Fundus photo, 45° FOV, 2352 by 1568 pixels — 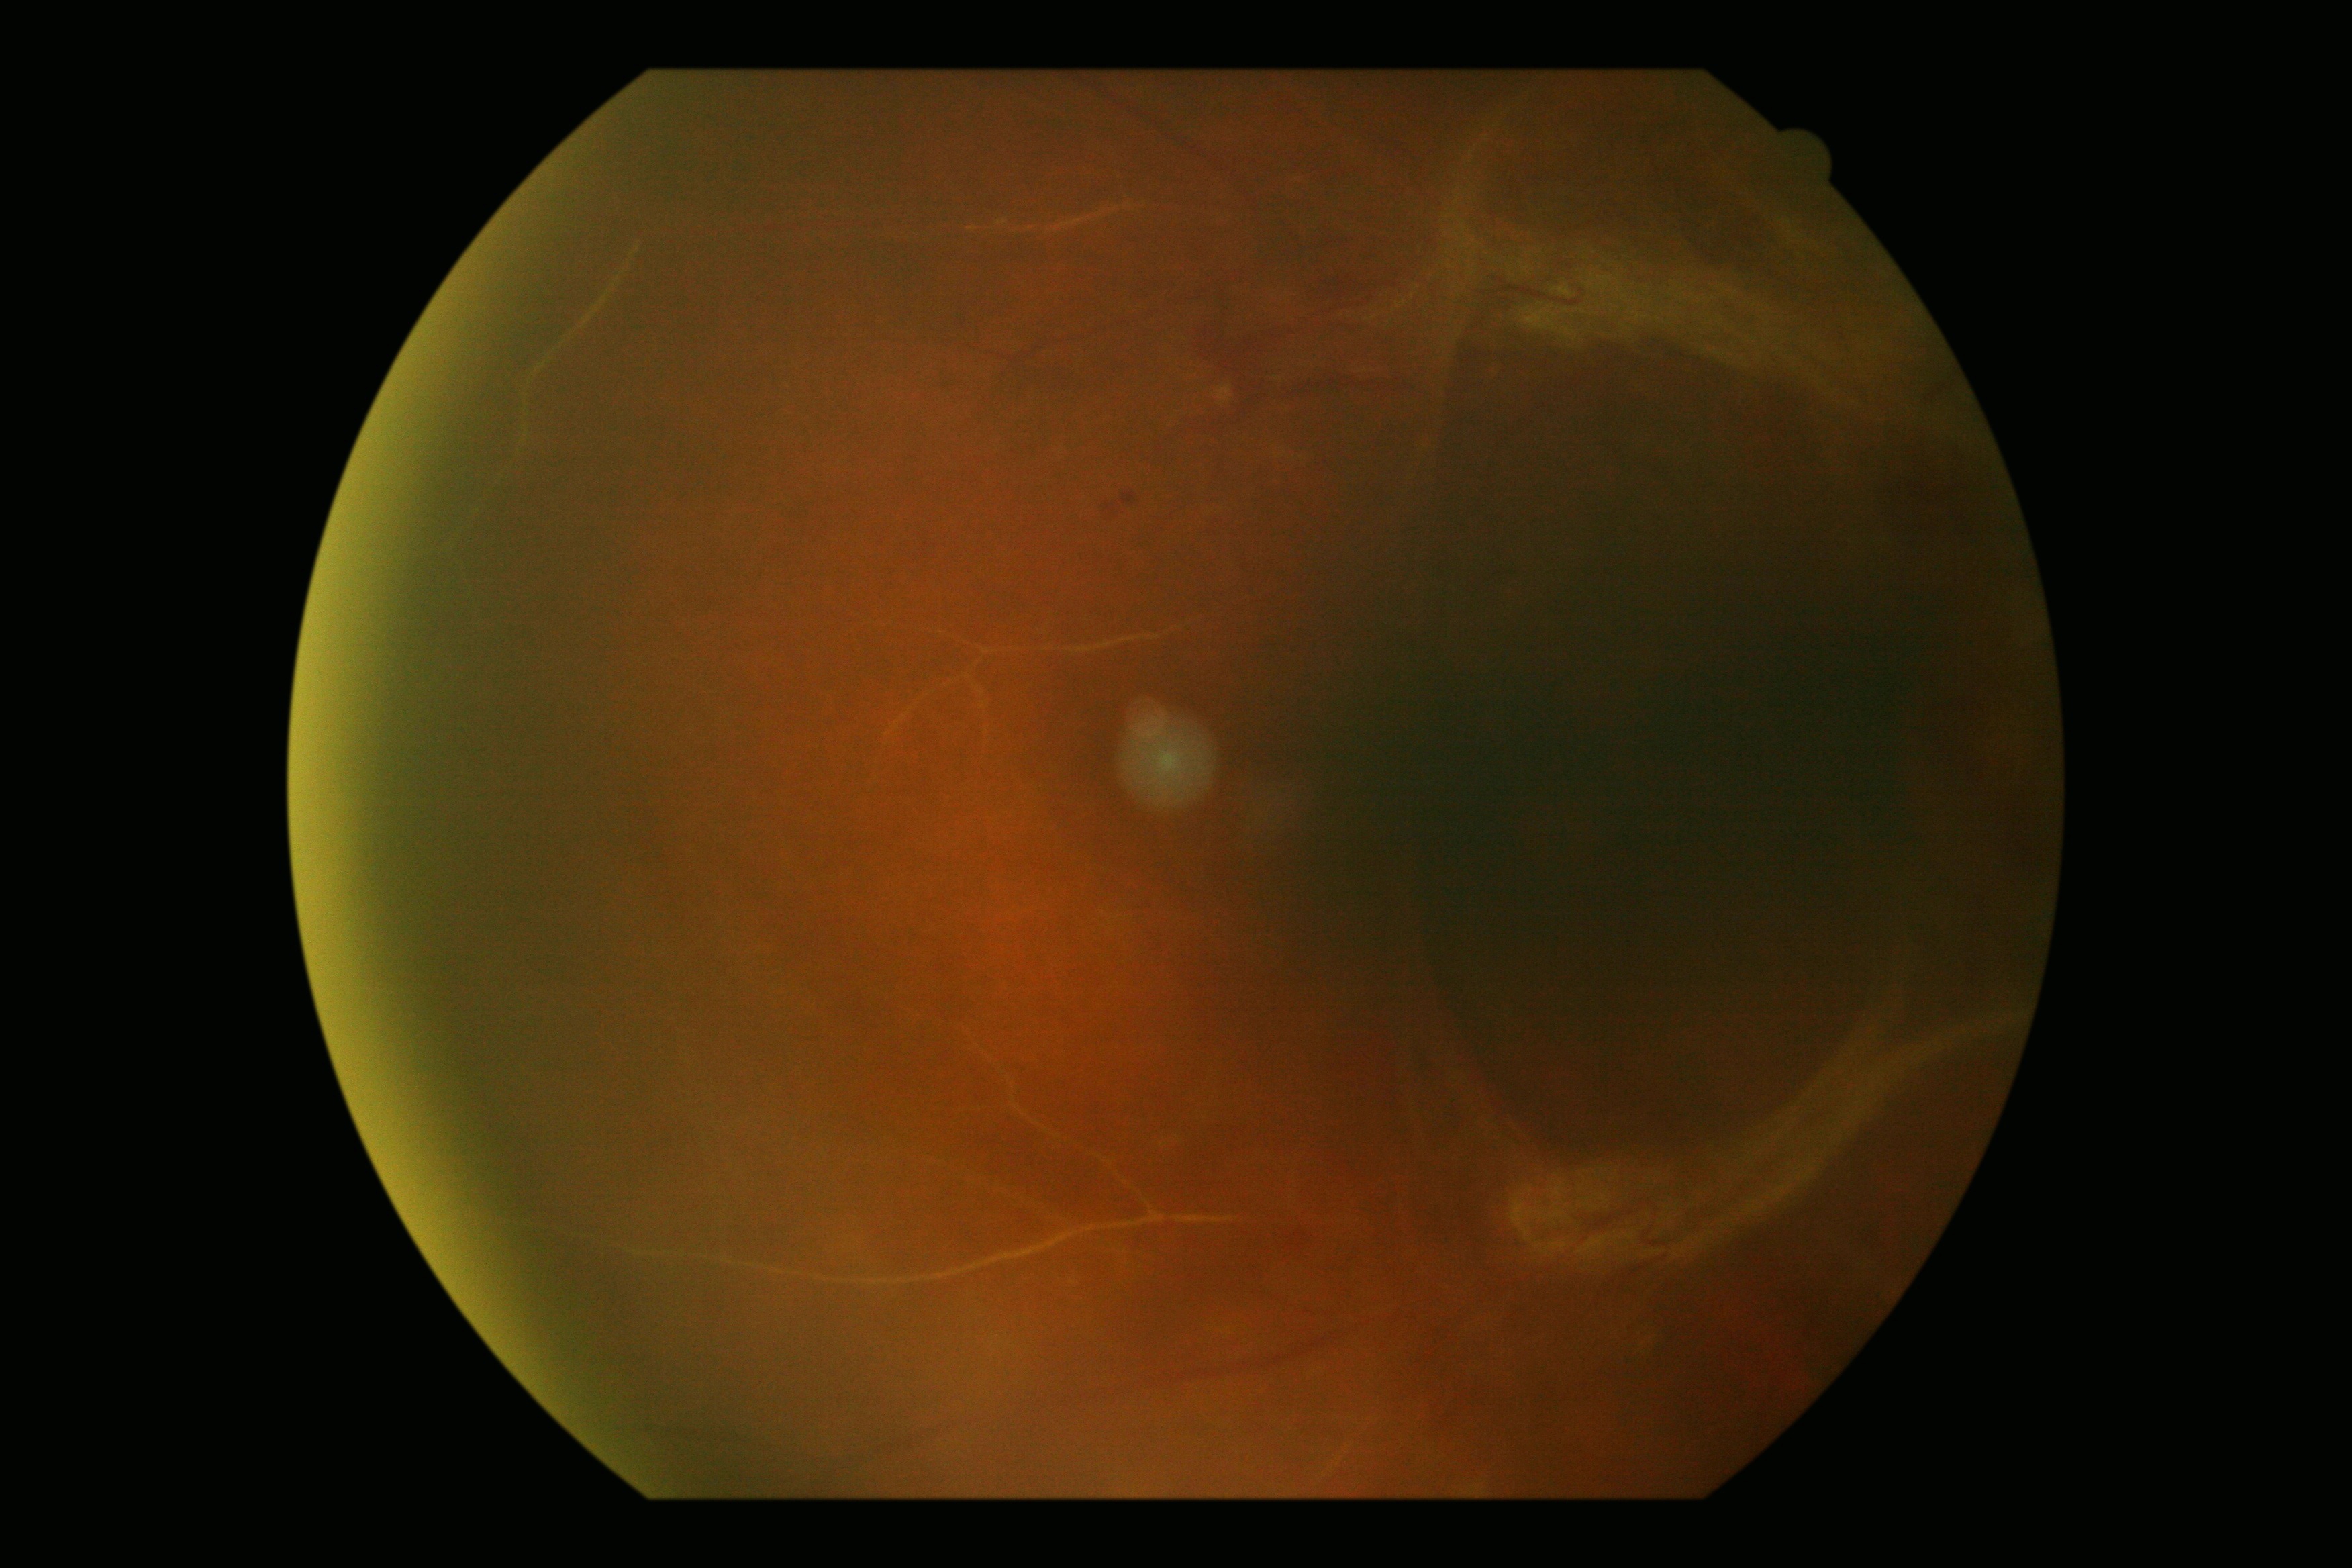 Findings:
• DR severity: 4